640x480. Clarity RetCam 3, 130° FOV. Infant wide-field fundus photograph:
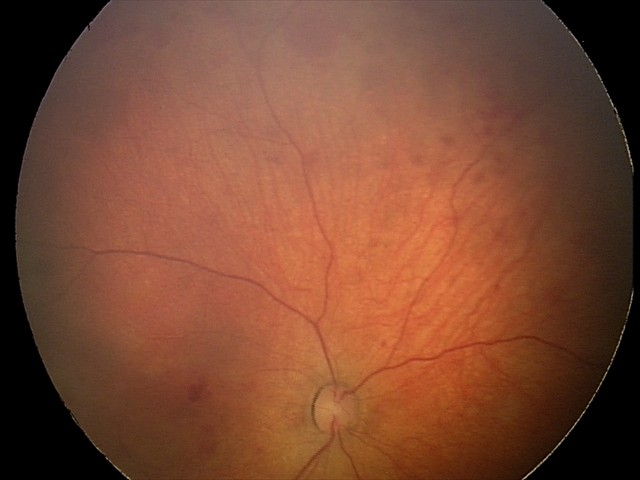
Q: What is the screening diagnosis?
A: retinal hemorrhages